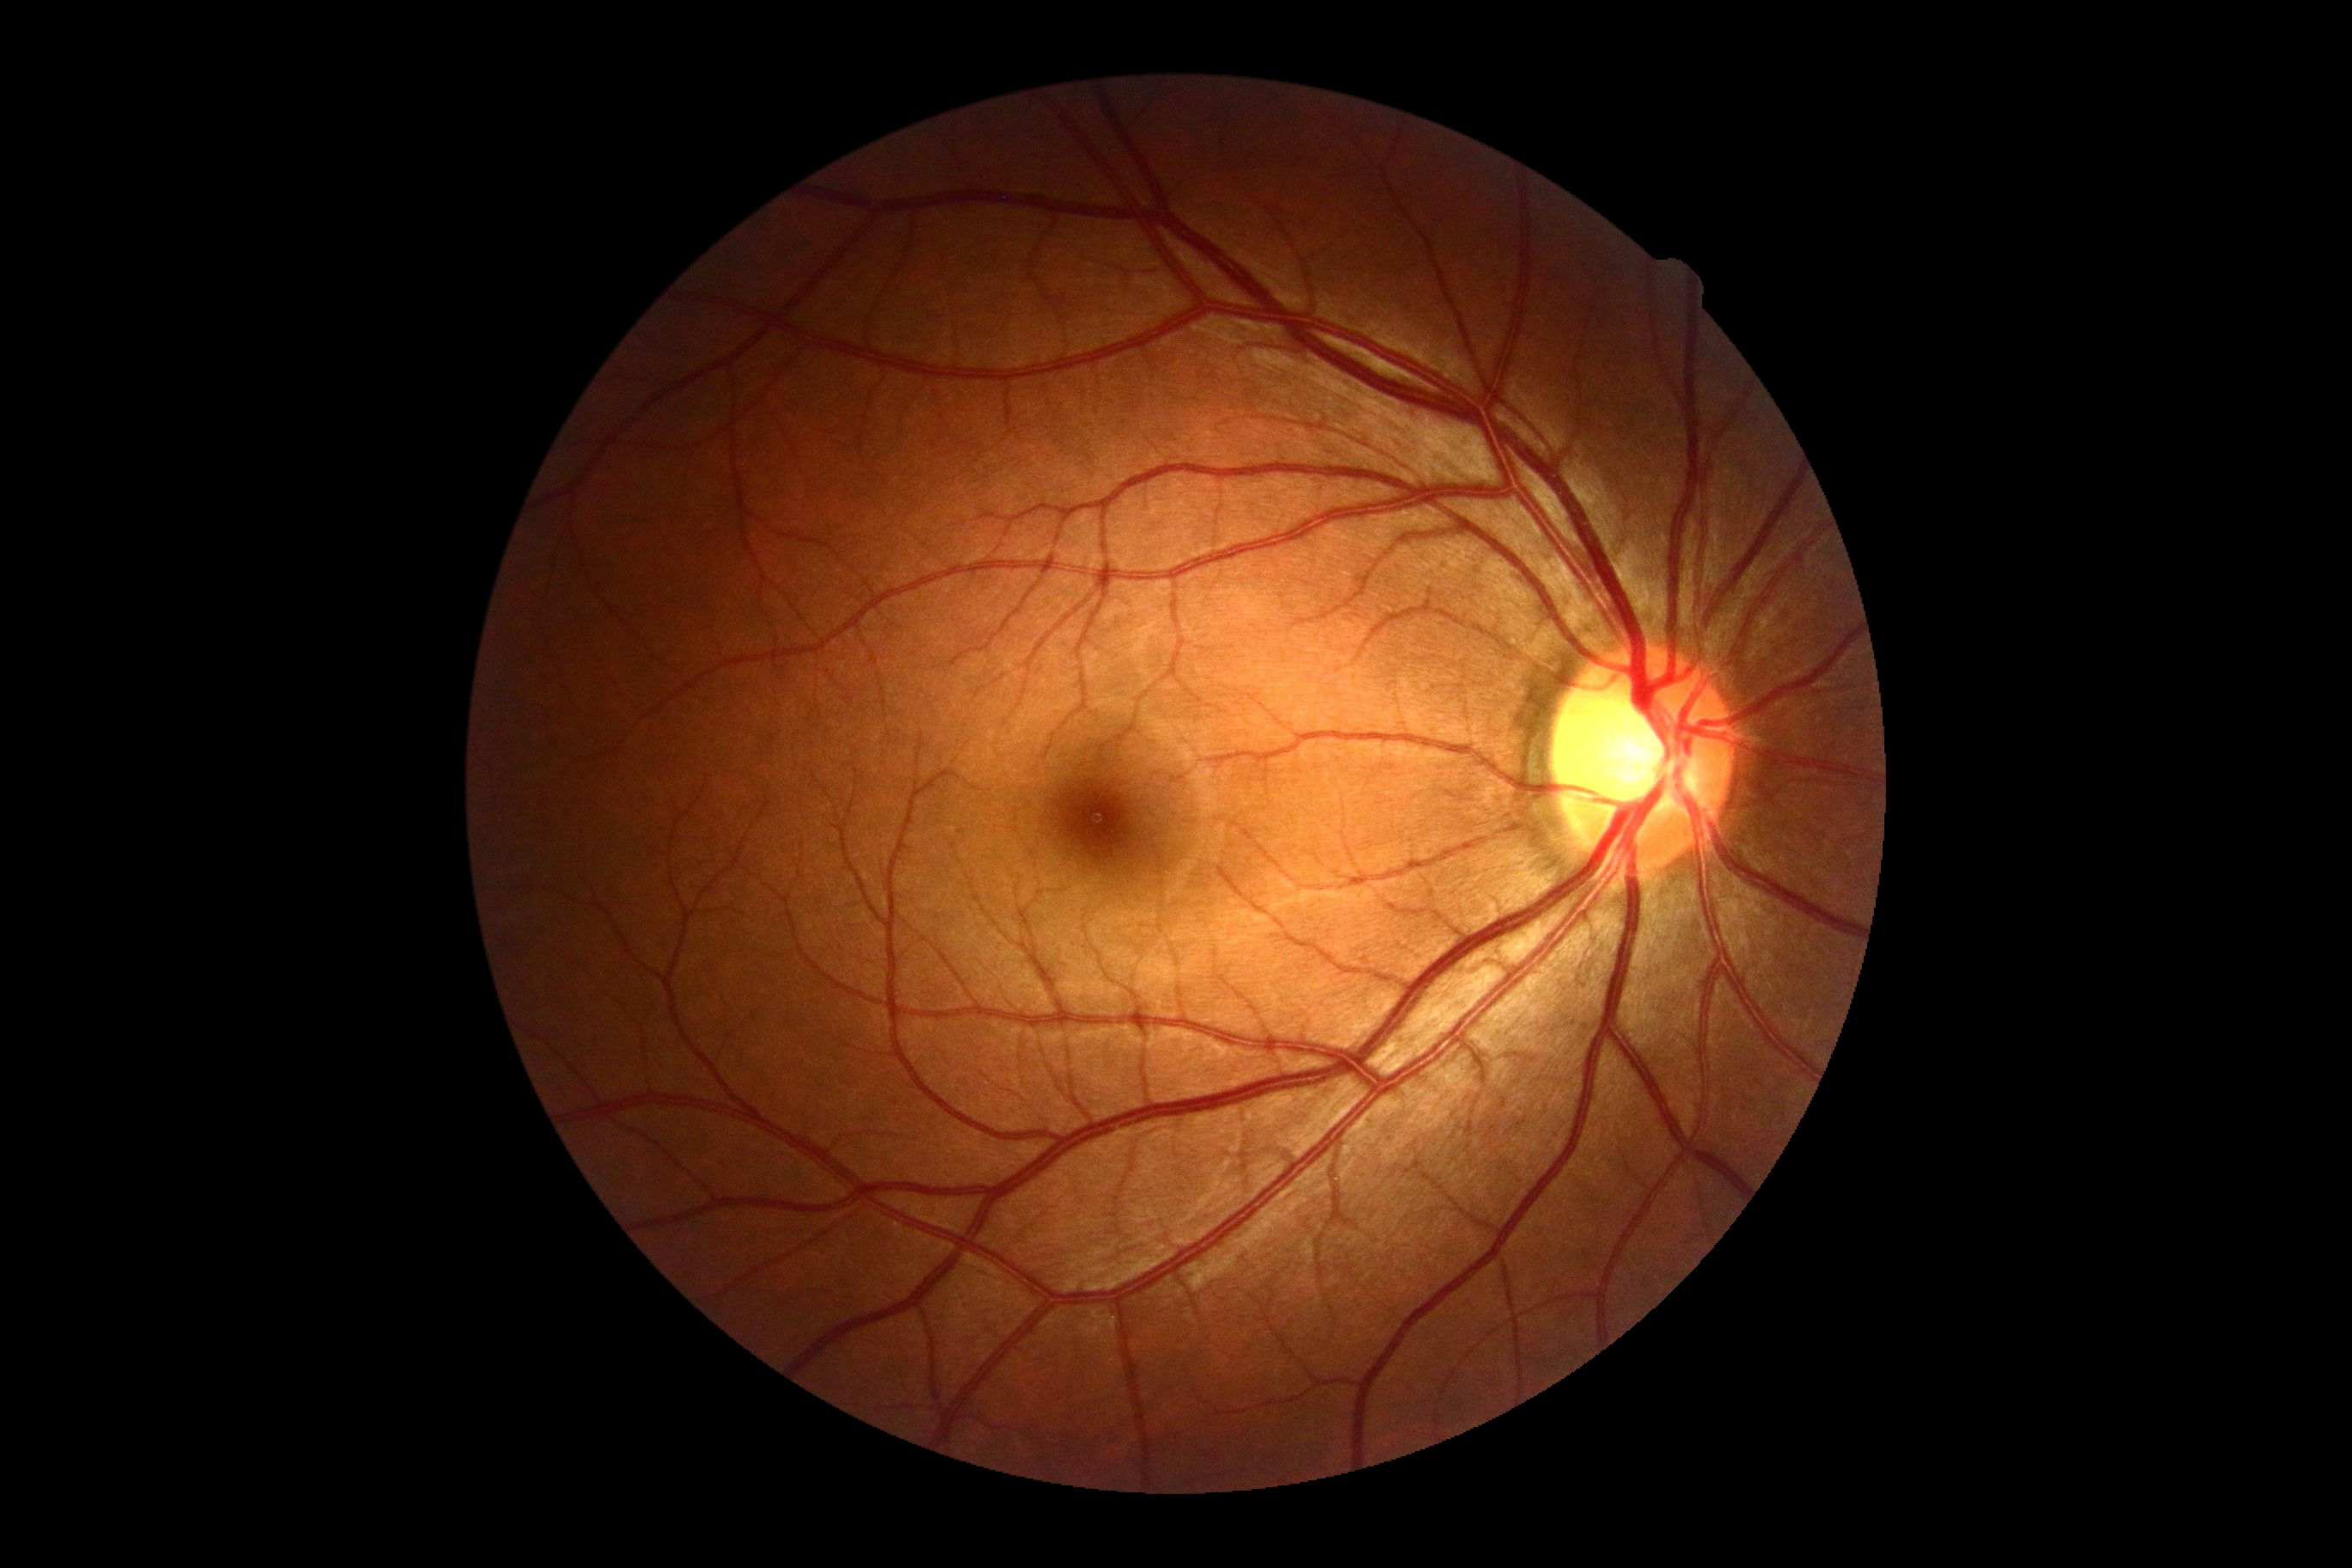

No apparent diabetic retinopathy. Diabetic retinopathy (DR): 0/4.